1504 x 1000 pixels; color fundus image.
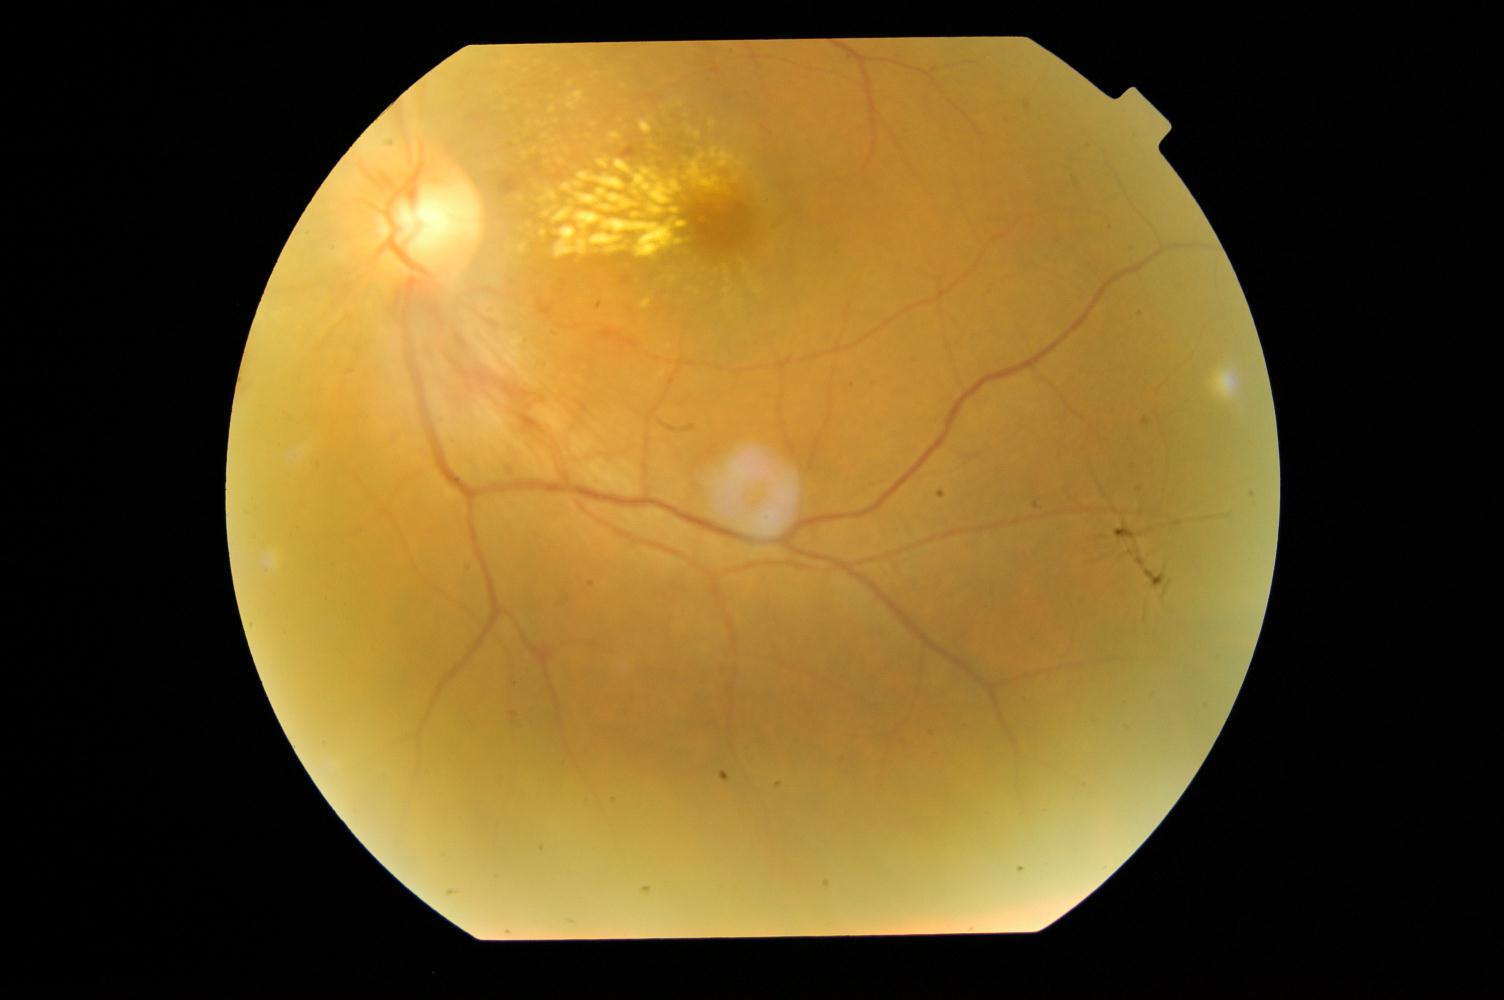
Showing hypertensive retinopathy (HTN).